Pediatric wide-field fundus photograph · 1240 x 1240 pixels.
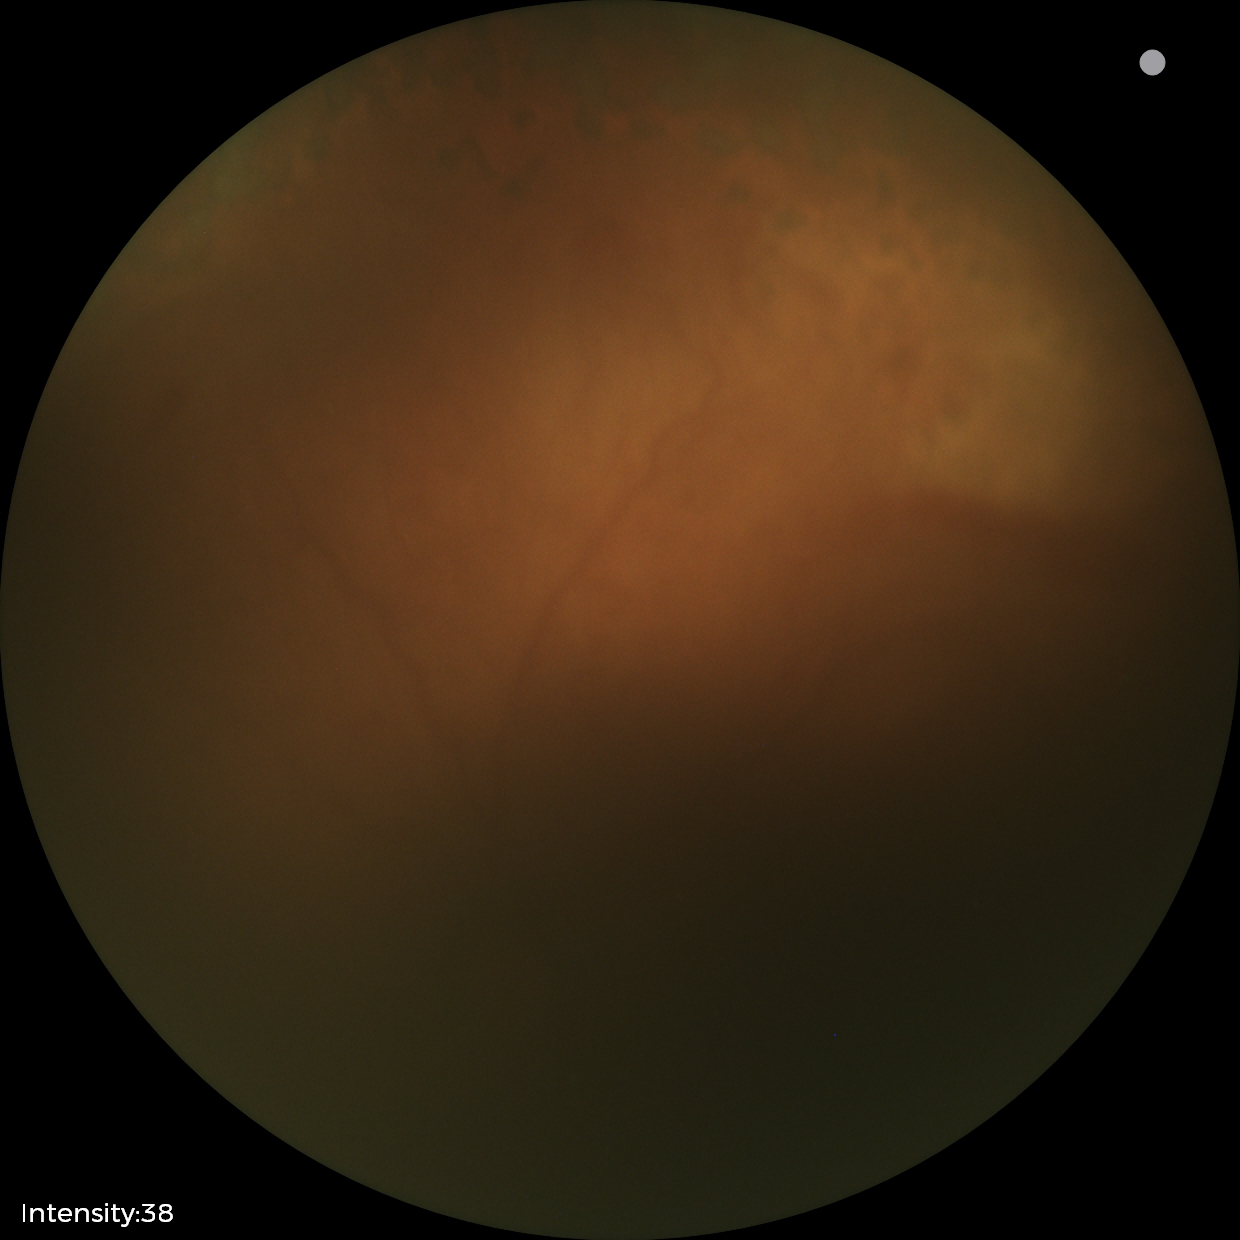 Series diagnosed as status post ROP. Plus disease absent.